2184x1690. 45-degree field of view.
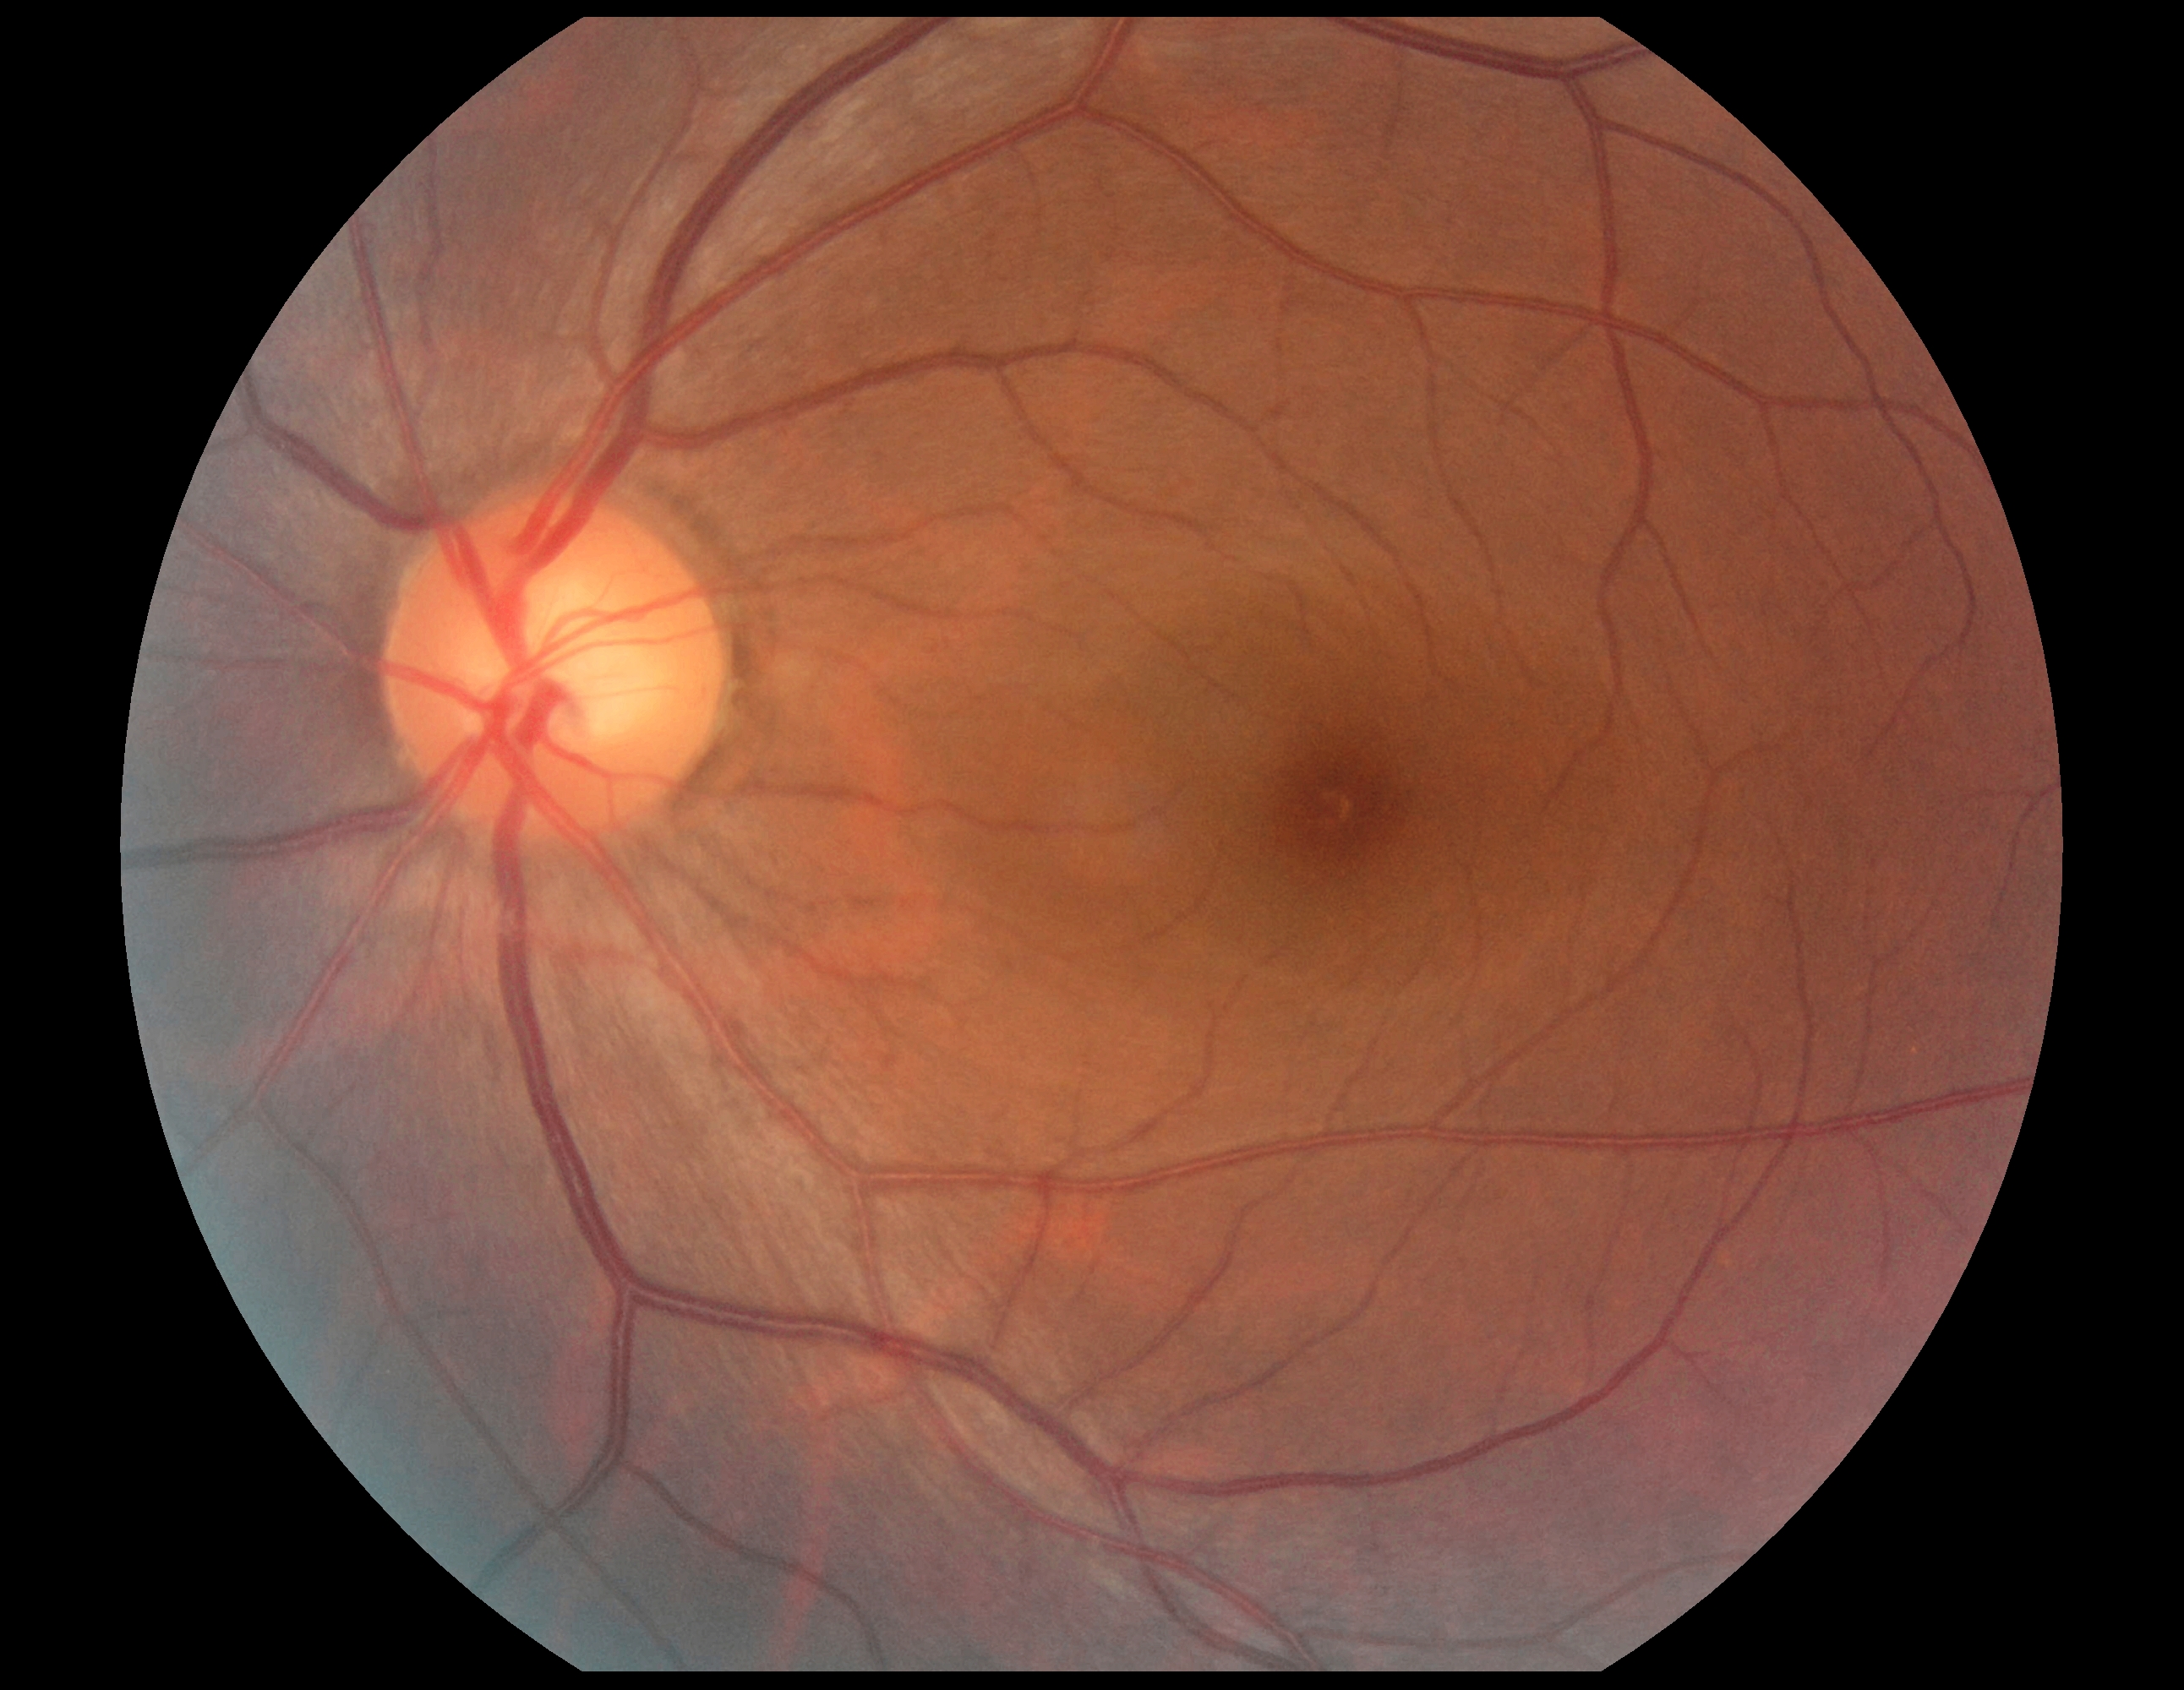
dr_grade: grade 0 (no apparent retinopathy)